1240x1240px · infant wide-field fundus photograph: 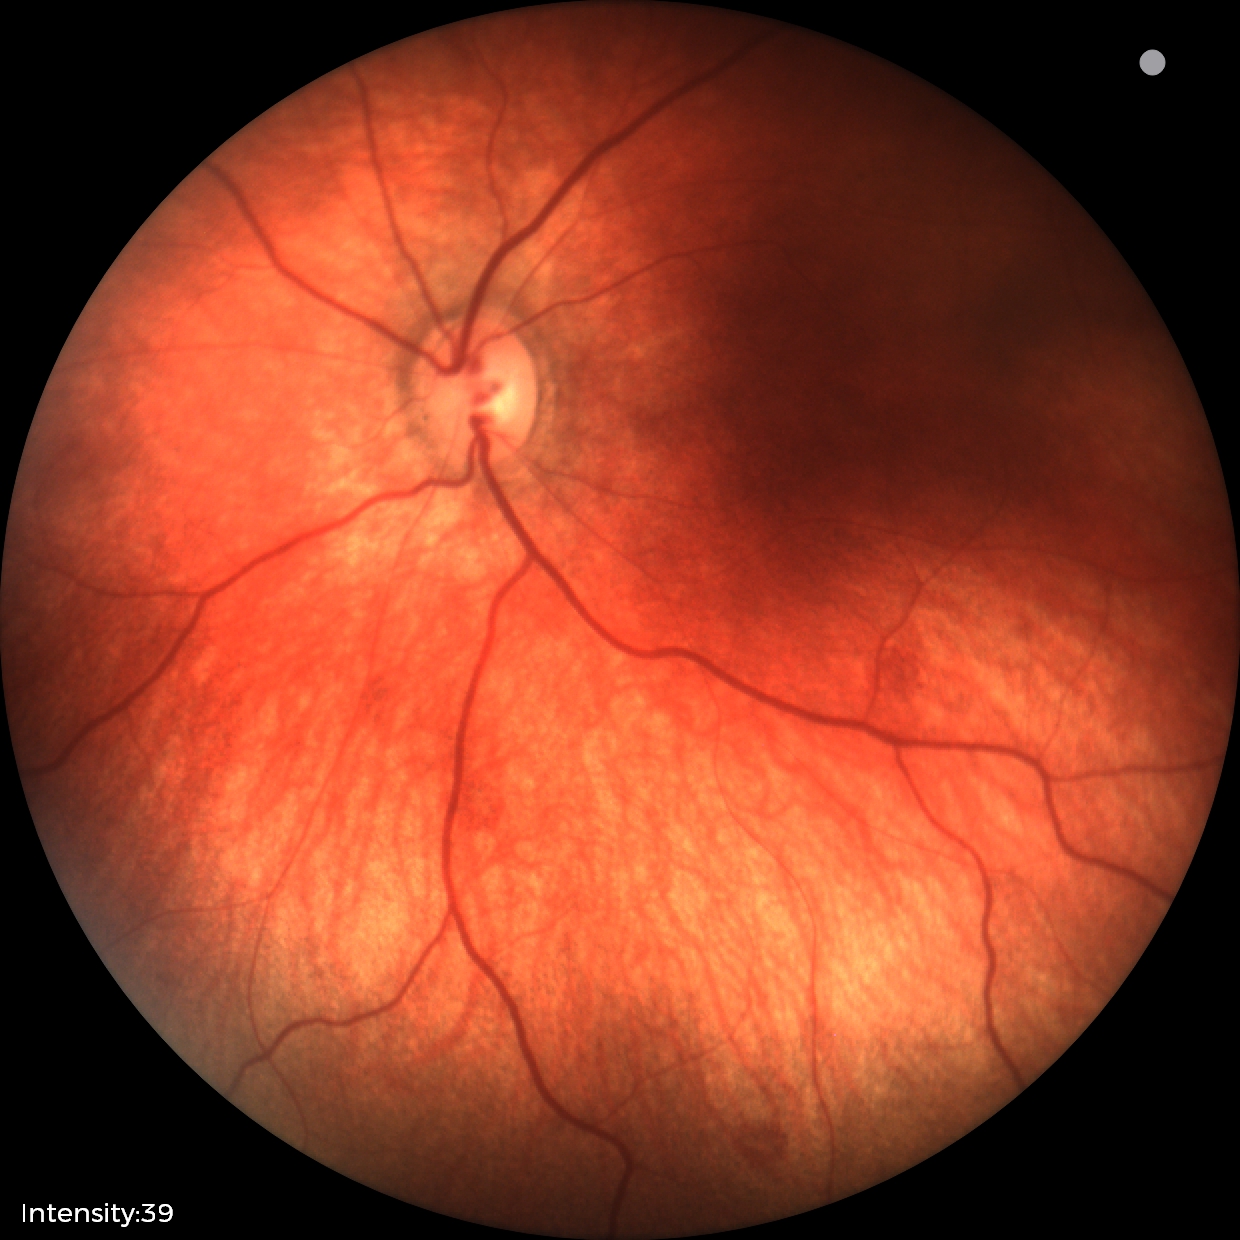
Screening examination consistent with retinal hemorrhages.